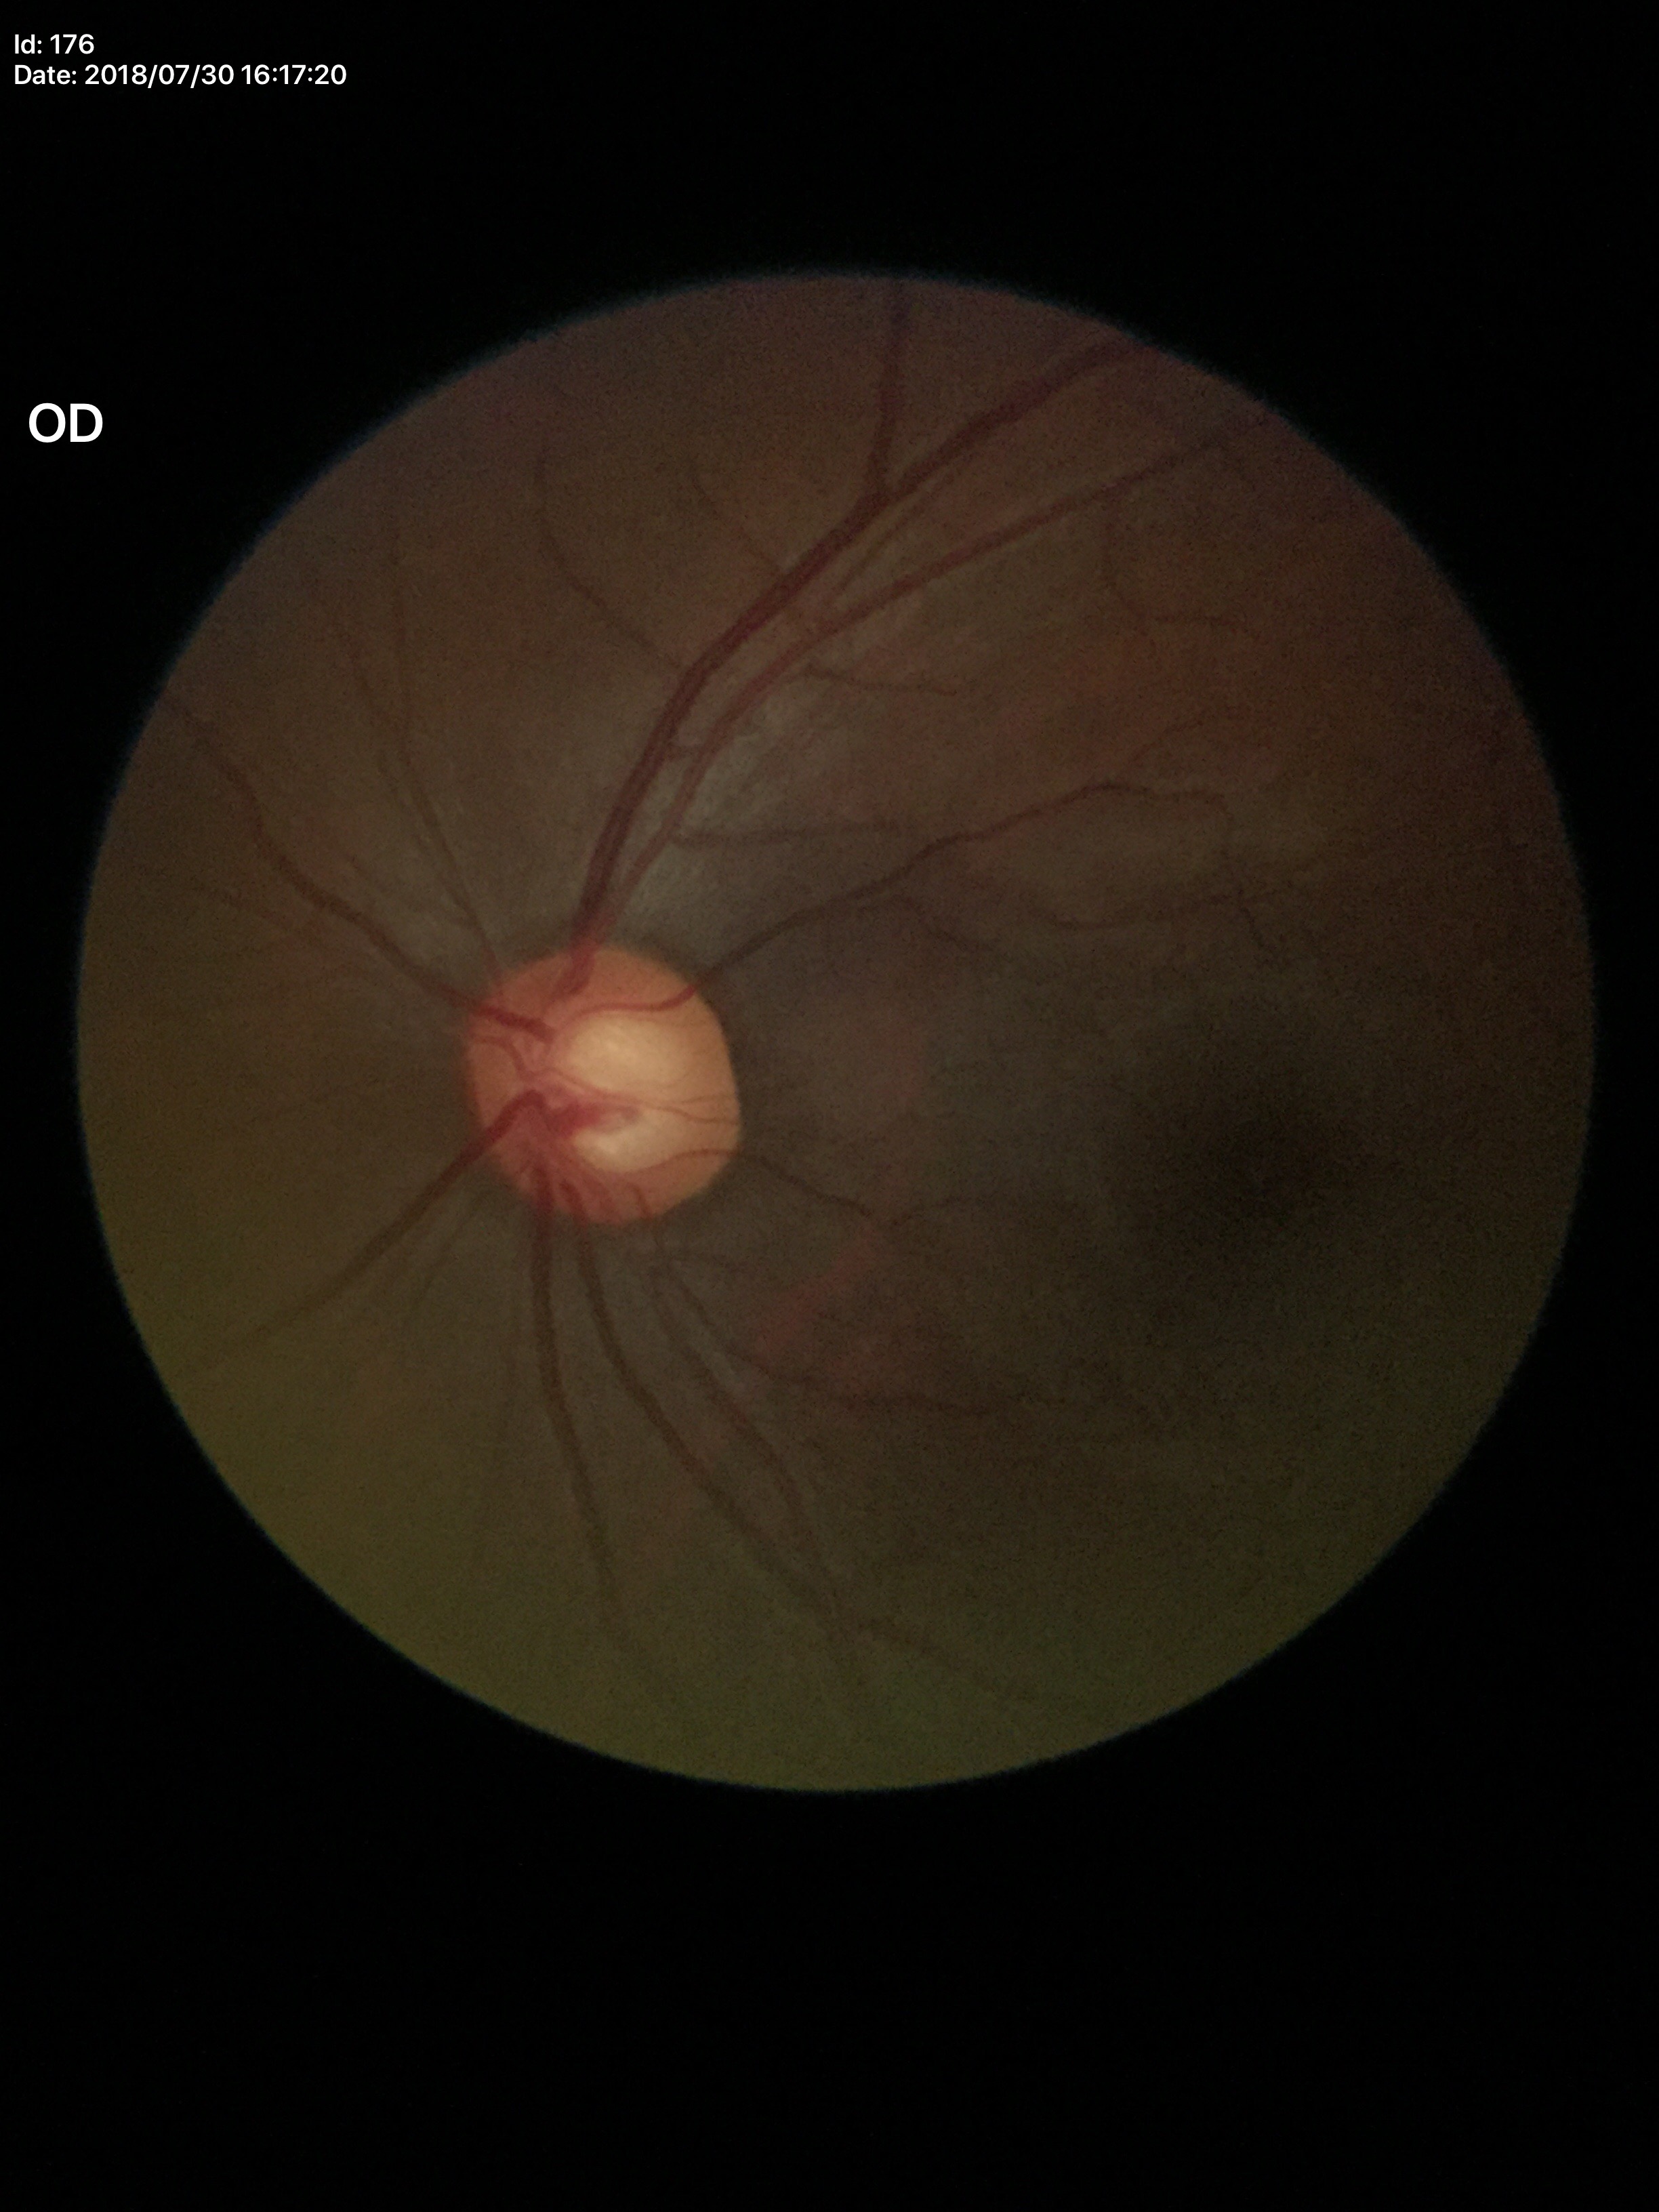

Suspect for glaucomatous optic neuropathy (four of five ophthalmologists flagged glaucoma suspect).
Horizontal cup-to-disc ratio of 0.59.
Vertical cup-to-disc ratio: 0.64.